Color fundus photograph. 512x512px:
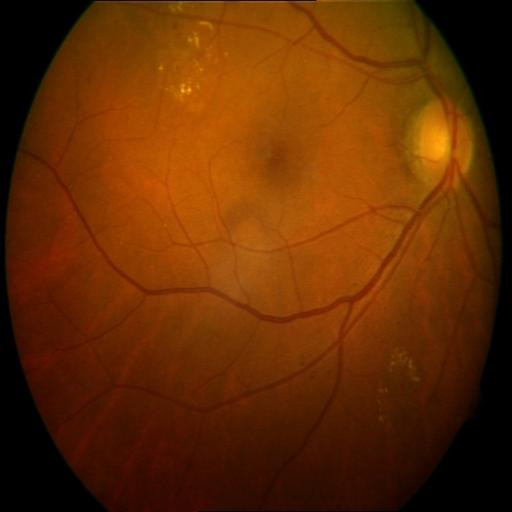
There is evidence of exudation.